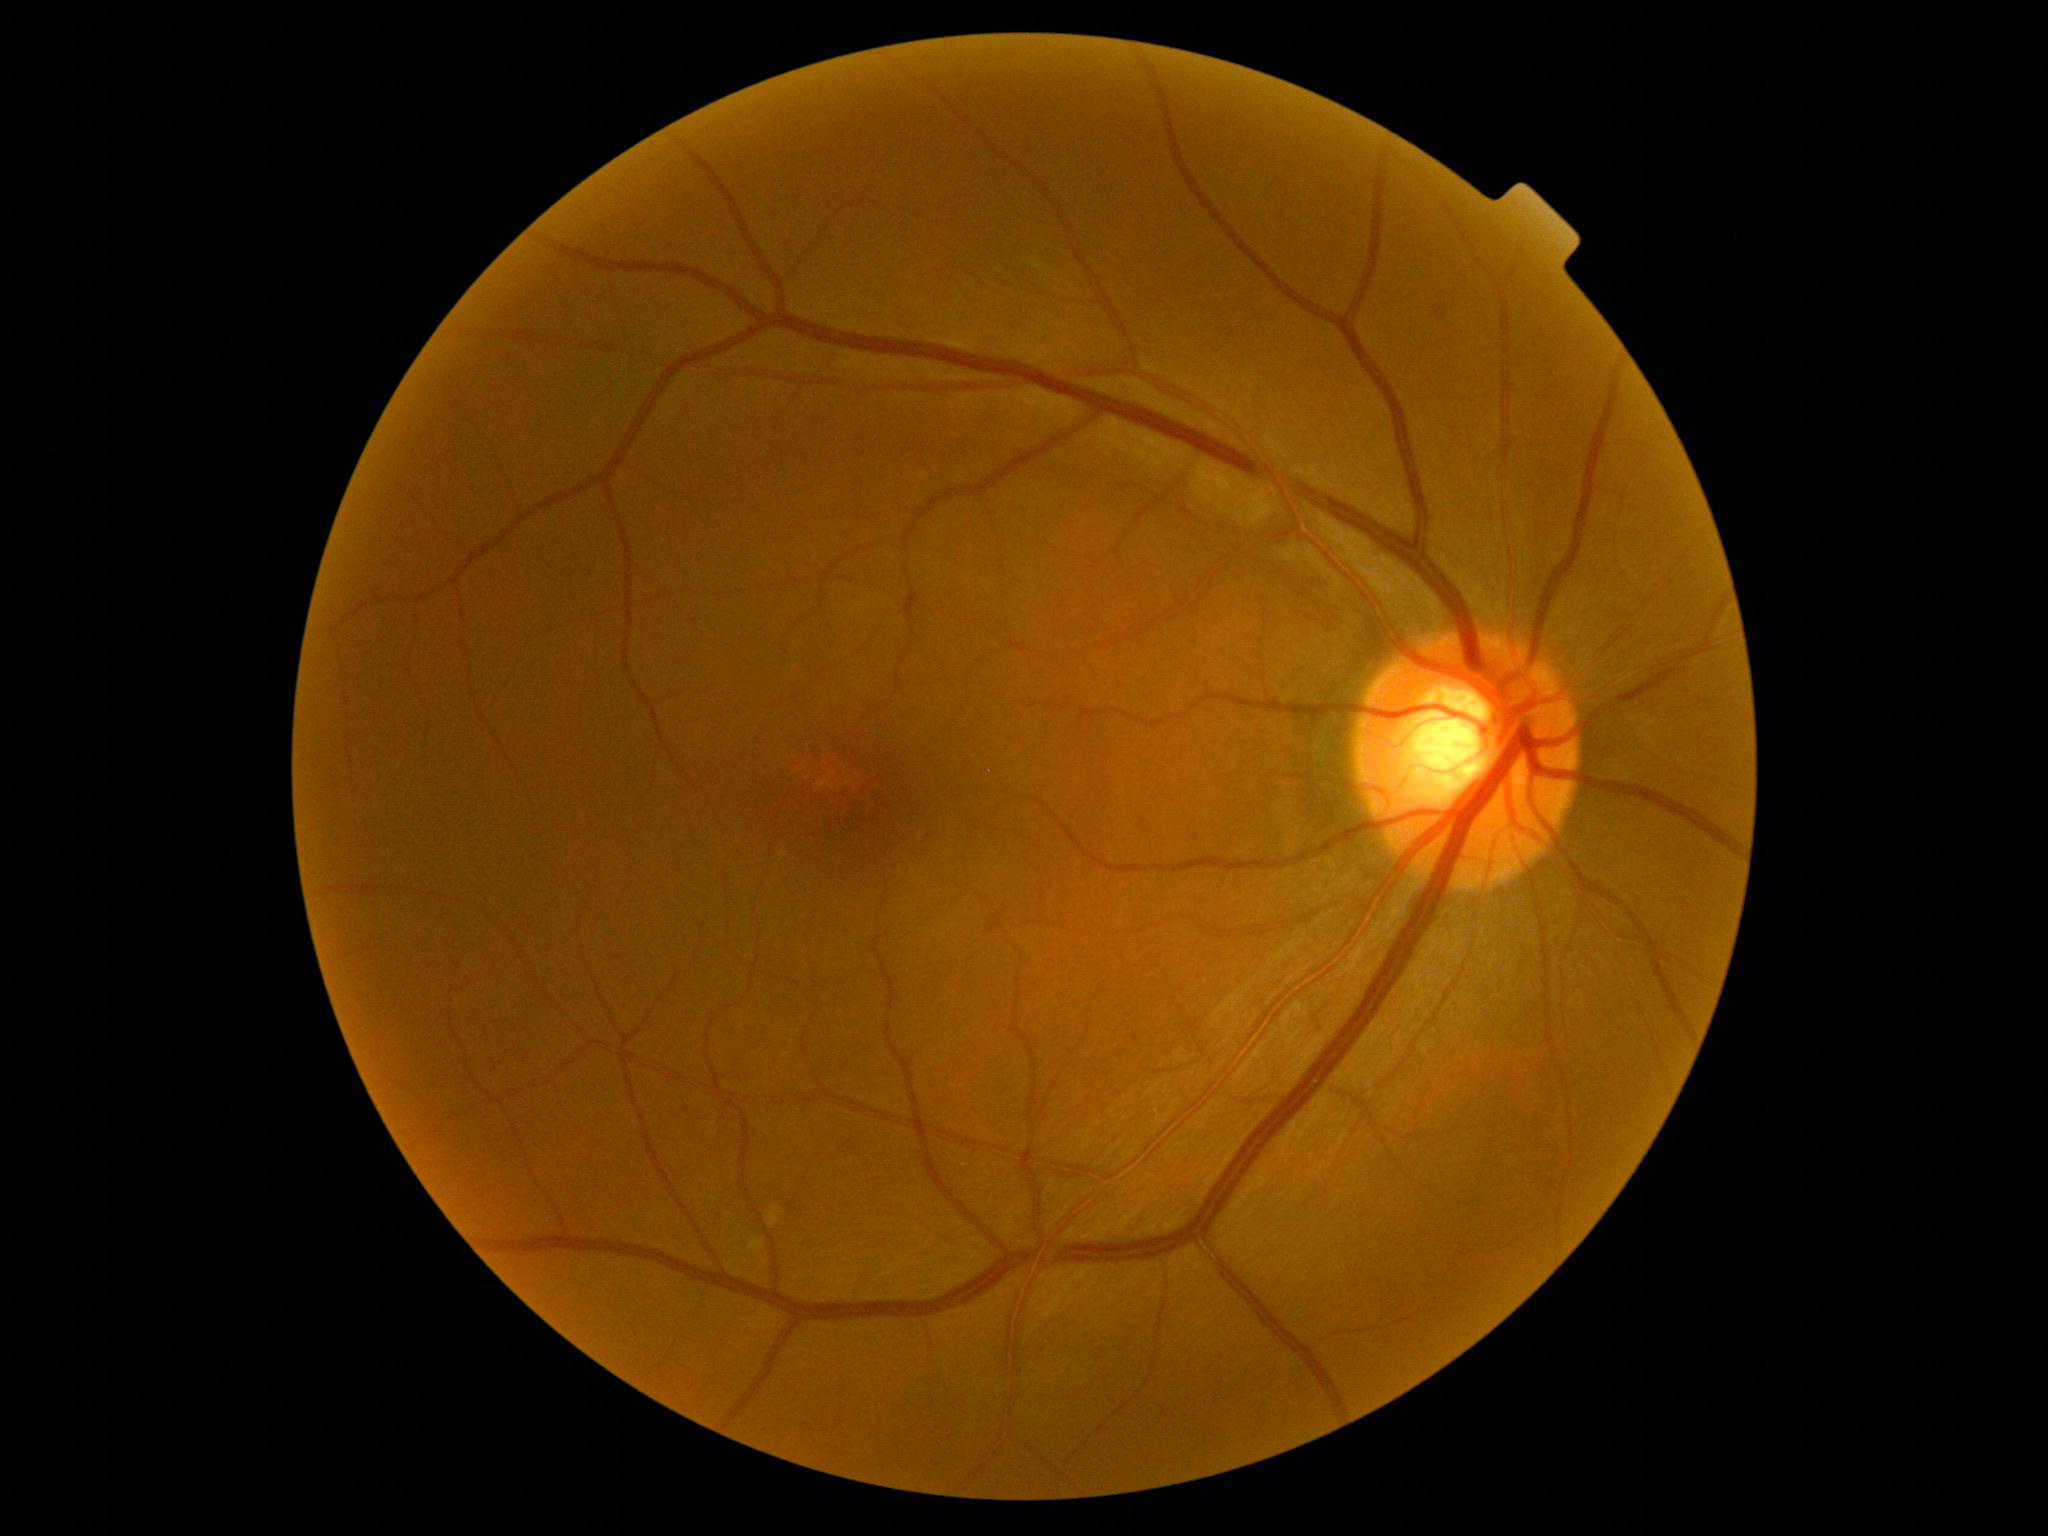 DR grade = 1 (mild NPDR).